45° FOV · 2048 x 1536 pixels:
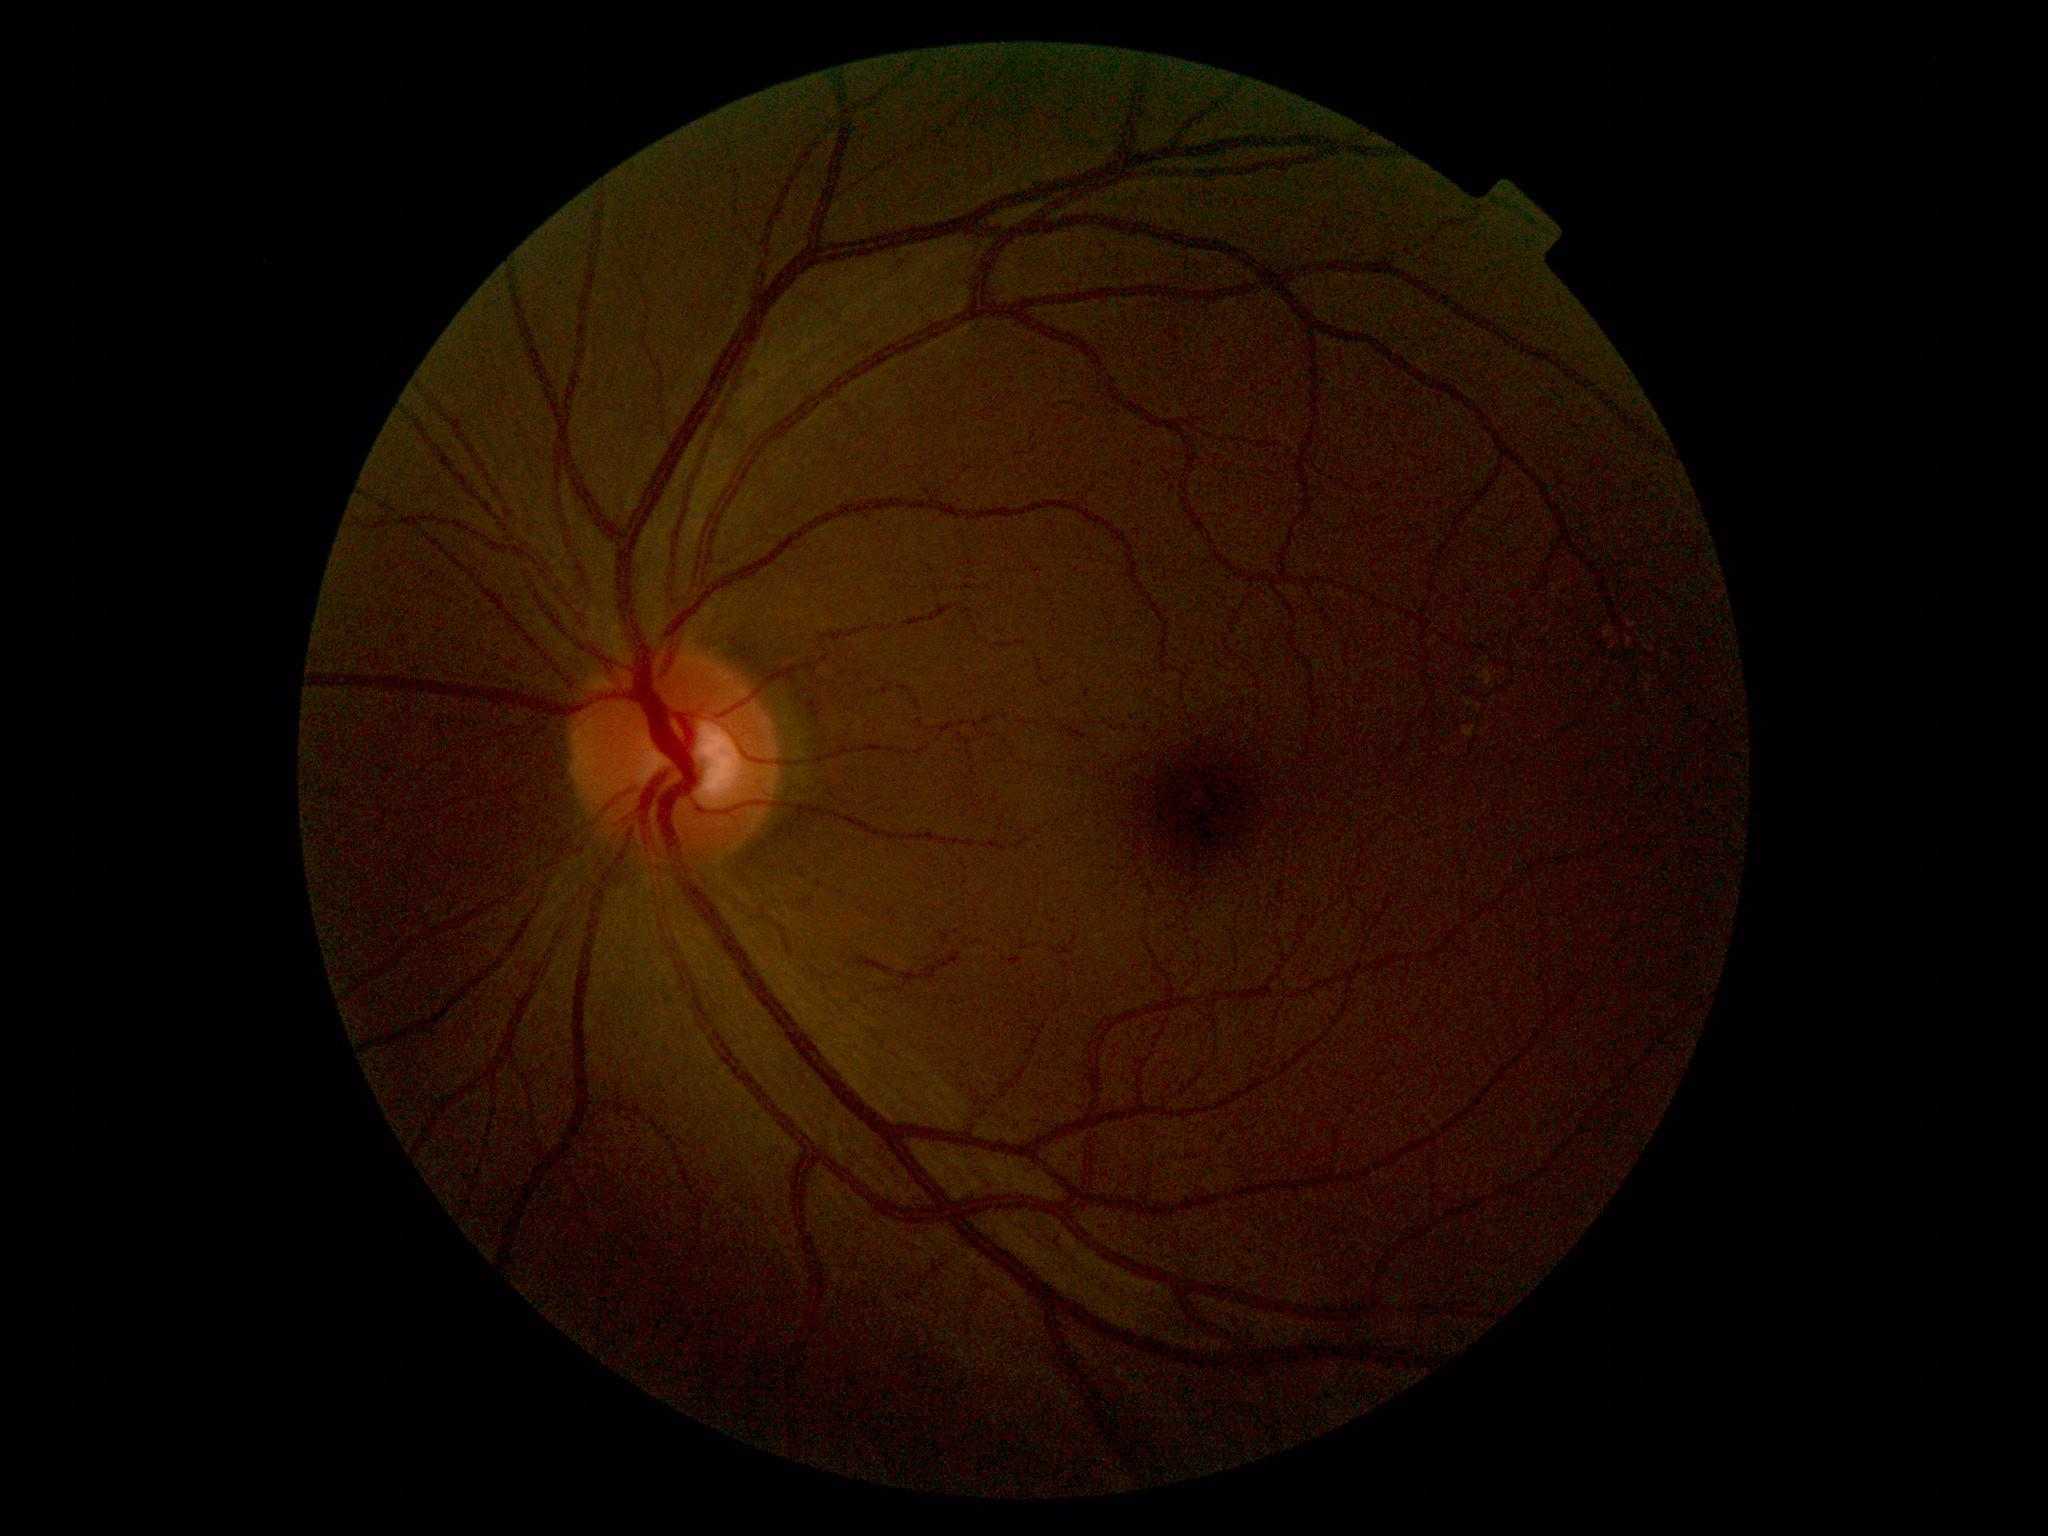

DR: grade 0 (no apparent retinopathy).